Axial length: 26.22 mm; color fundus photograph; non-mydriatic; acquired with a Topcon TRC-NW400; 45-year-old patient; refraction: -6.5 -2.25 × 5°; optic disc-centered; 2212x1661:
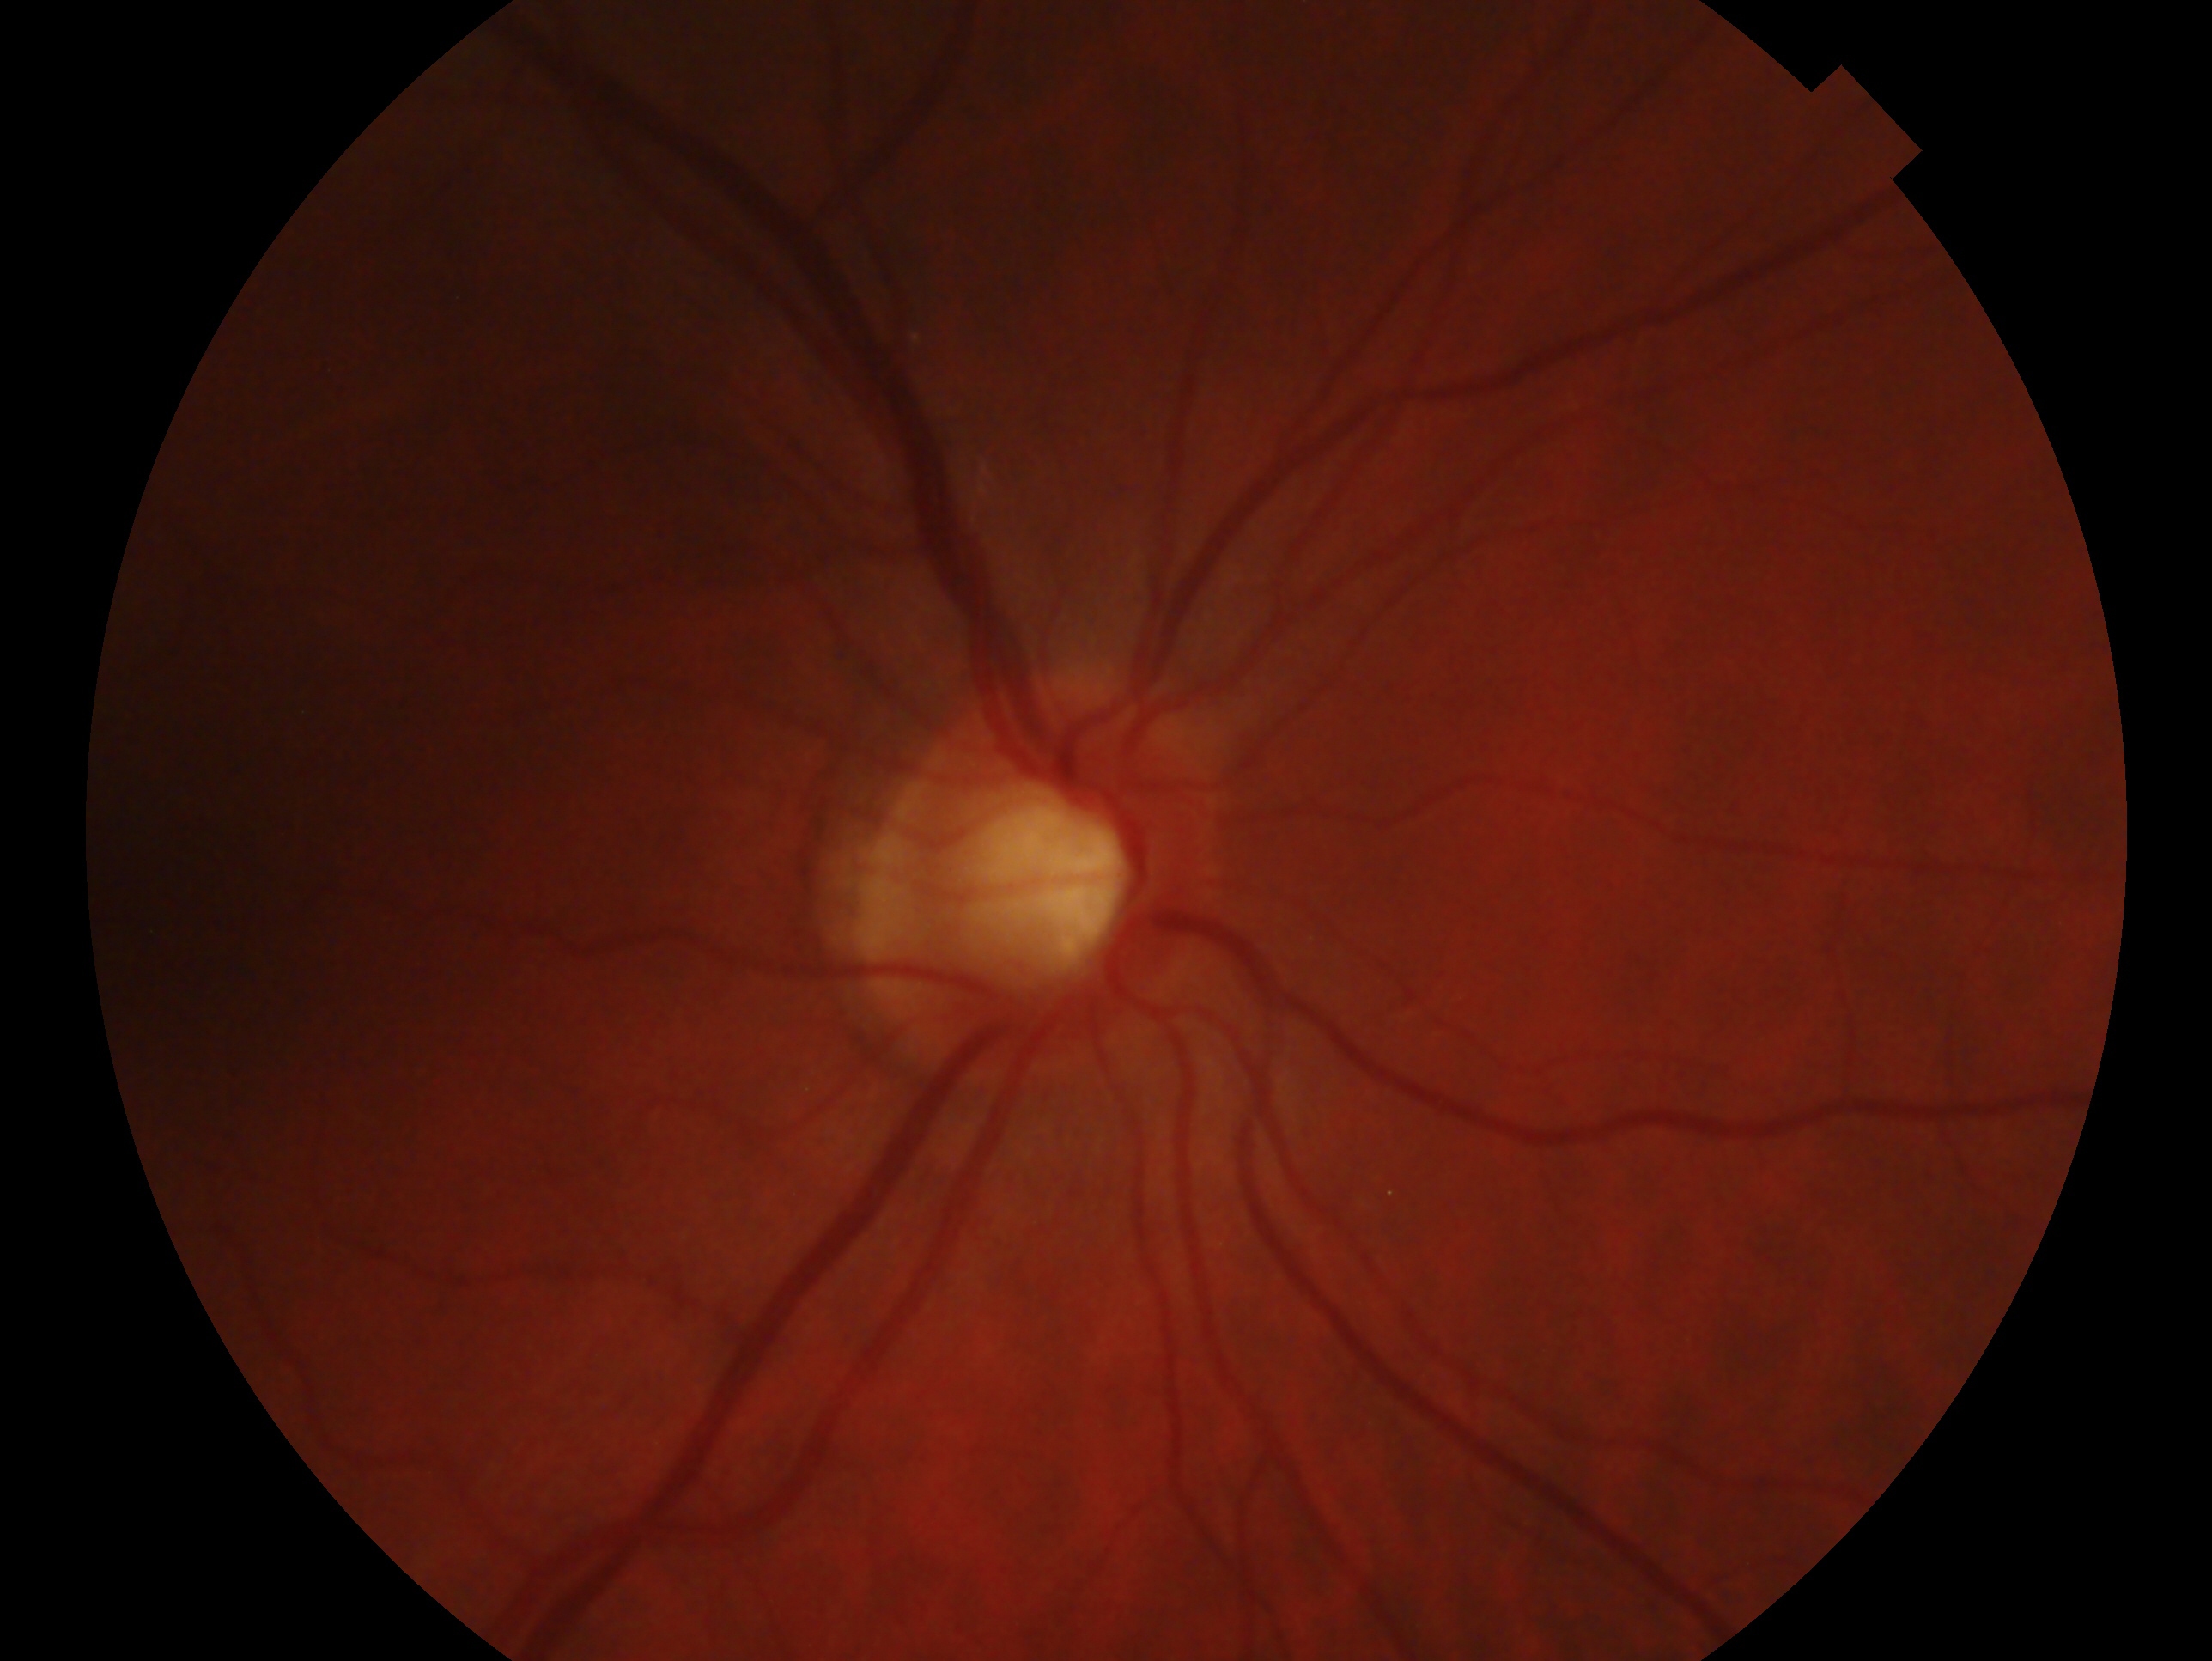
This is the oculus dexter.
Assessment: no signs of glaucoma — no clinical evidence of glaucoma in this eye.